1240 x 1240 pixels · wide-field fundus image from infant ROP screening · captured with the Phoenix ICON (100° field of view) — 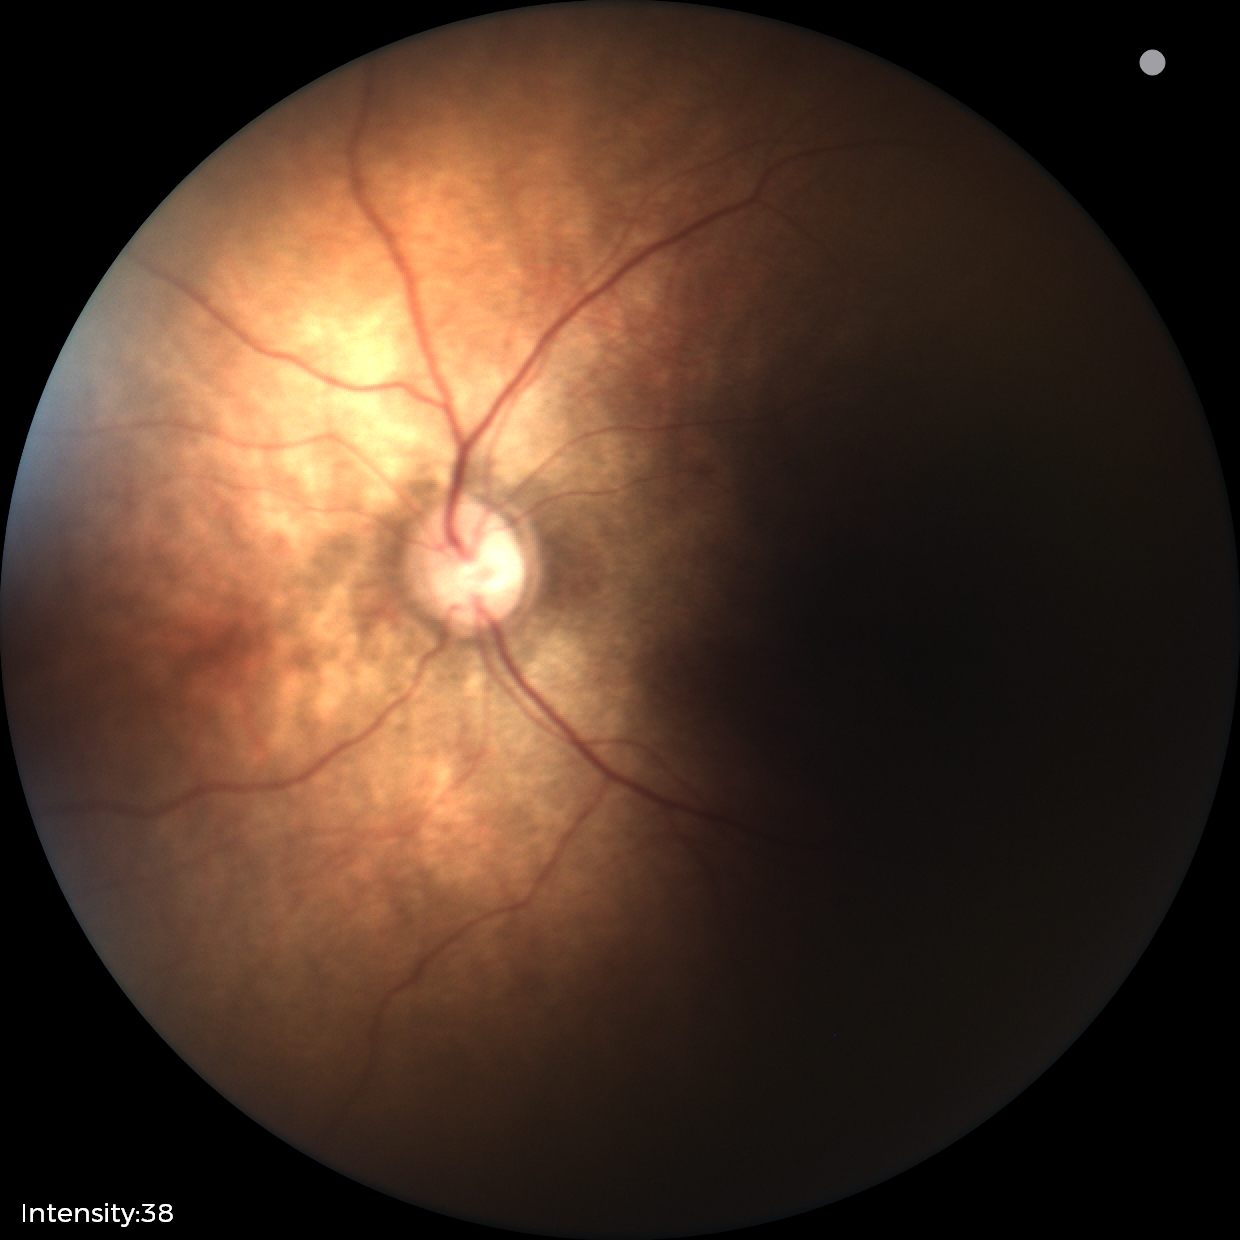

No retinal pathology identified on screening.